Wide-field fundus photograph from neonatal ROP screening · camera: Phoenix ICON (100° FOV):
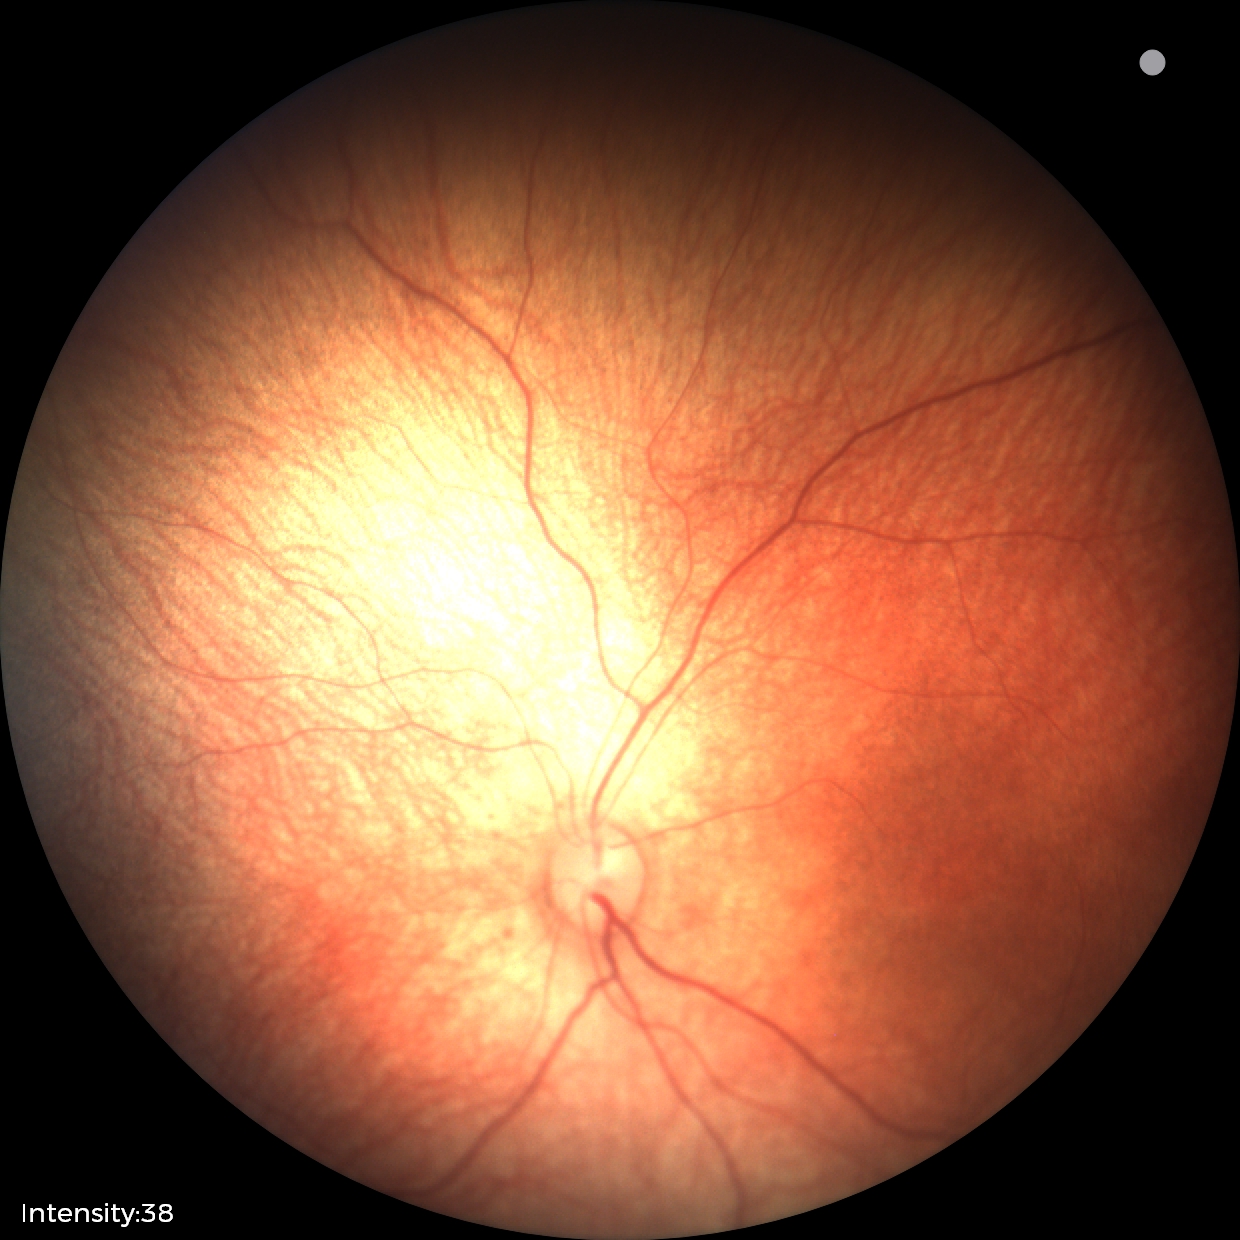 Physiological retinal appearance for postconceptual age.